FOV: 45 degrees.
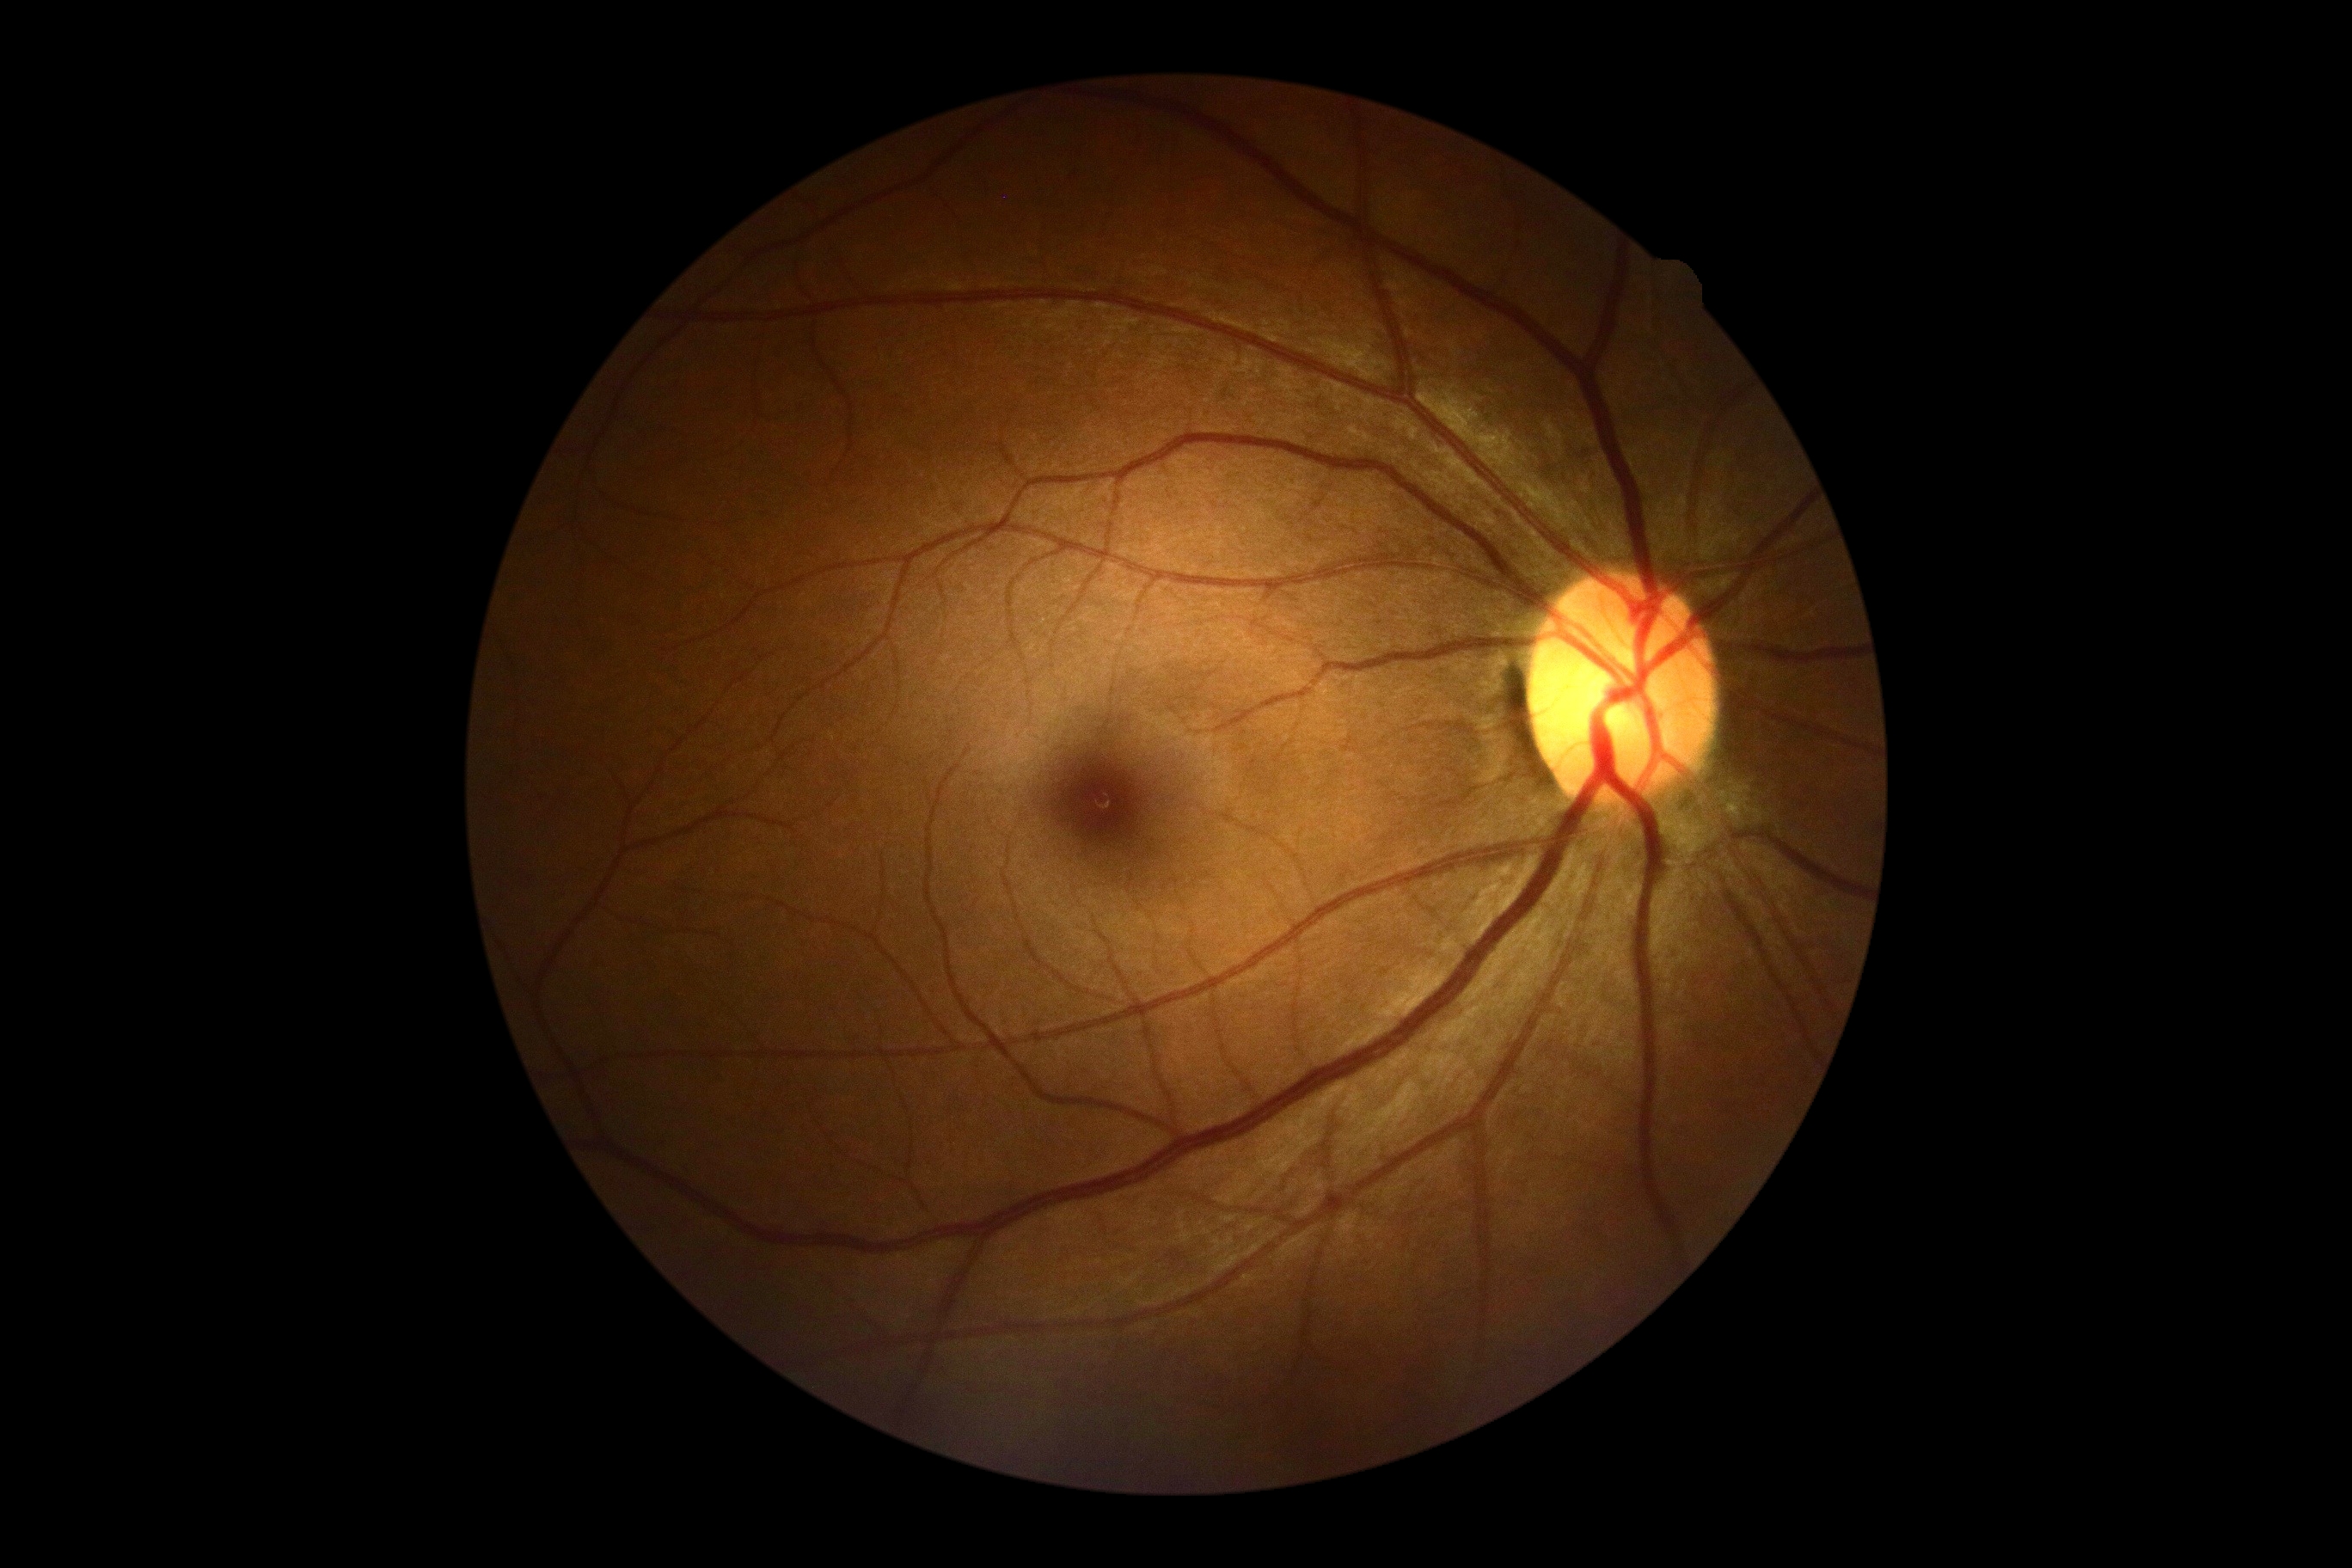
DR grade = no apparent retinopathy (0).